Image size 848x848, 45° FOV, diabetic retinopathy graded by the modified Davis classification, nonmydriatic
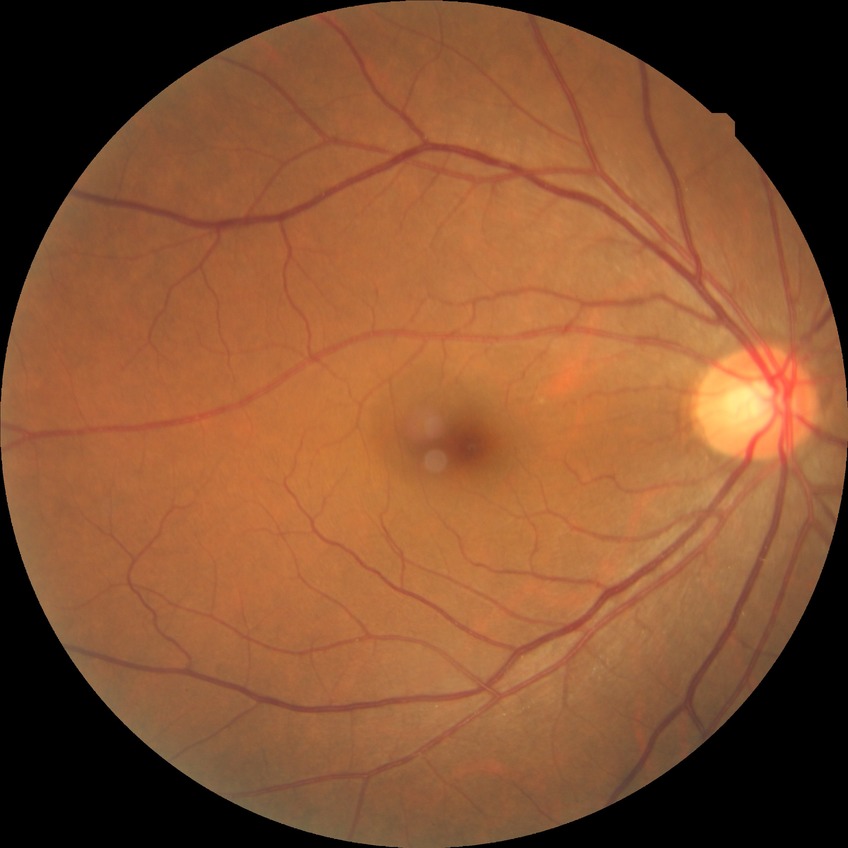 Diabetic retinopathy (DR) is no diabetic retinopathy (NDR).